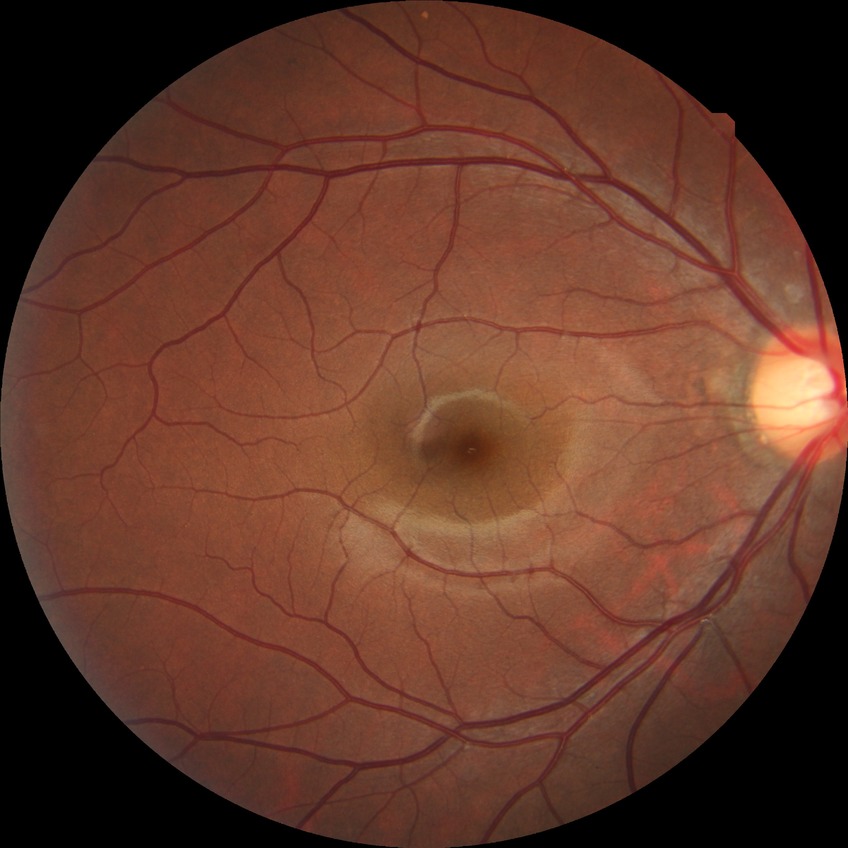
DR severity is NDR.